45° FOV · nonmydriatic — 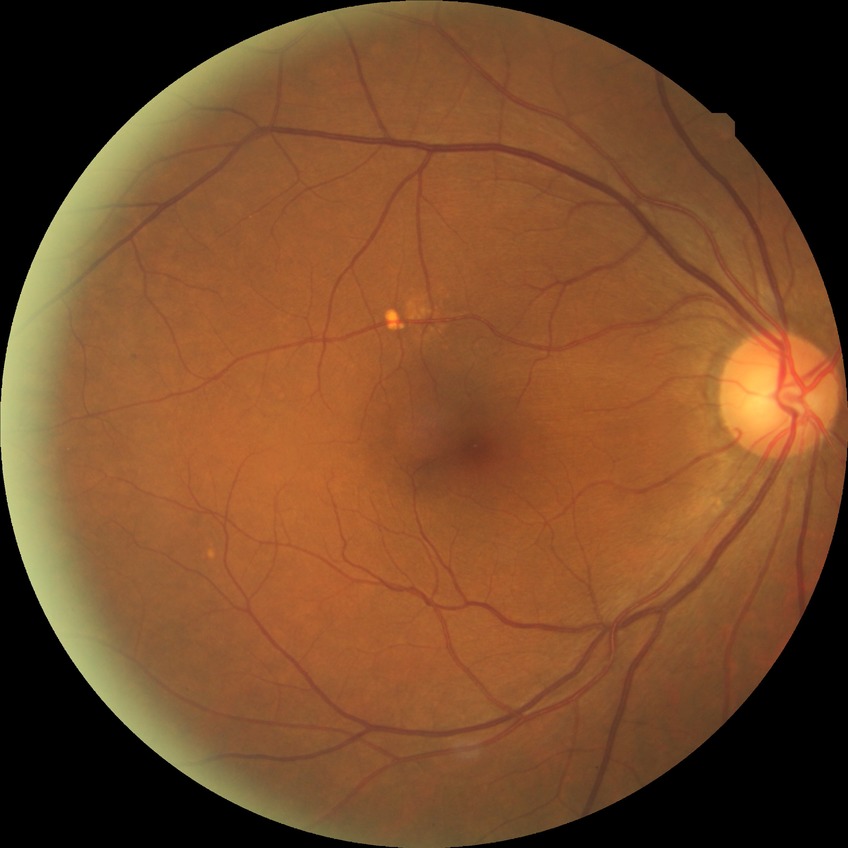 Davis grade is NDR.